Camera: NIDEK AFC-230.
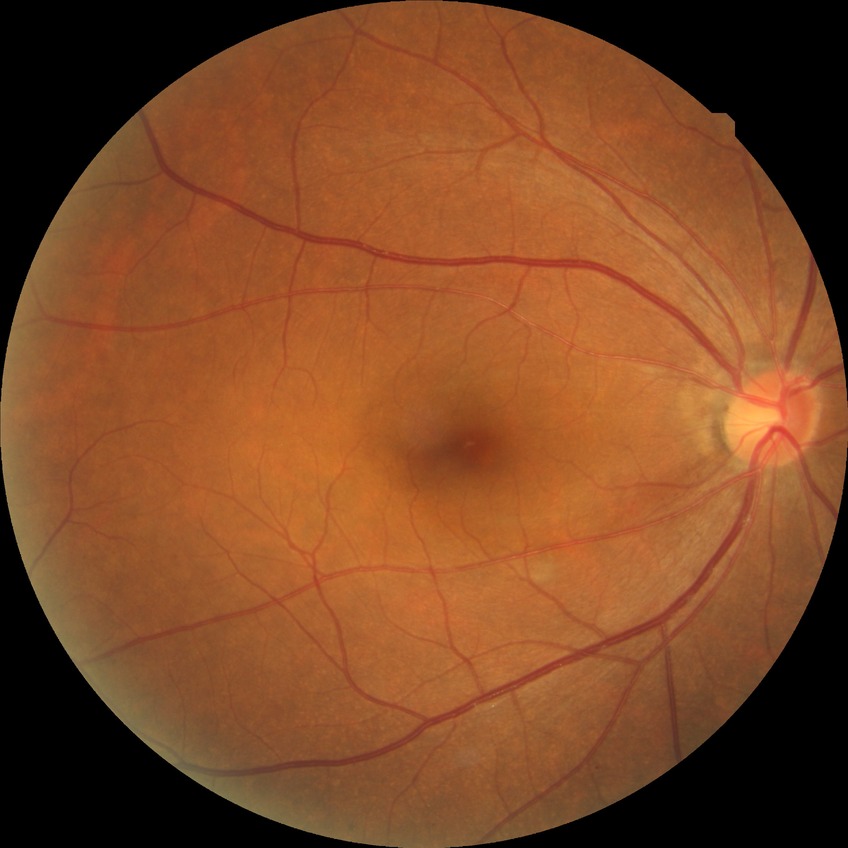

DR: NDR.